Image size 1240x1240 · wide-field fundus photograph of an infant: 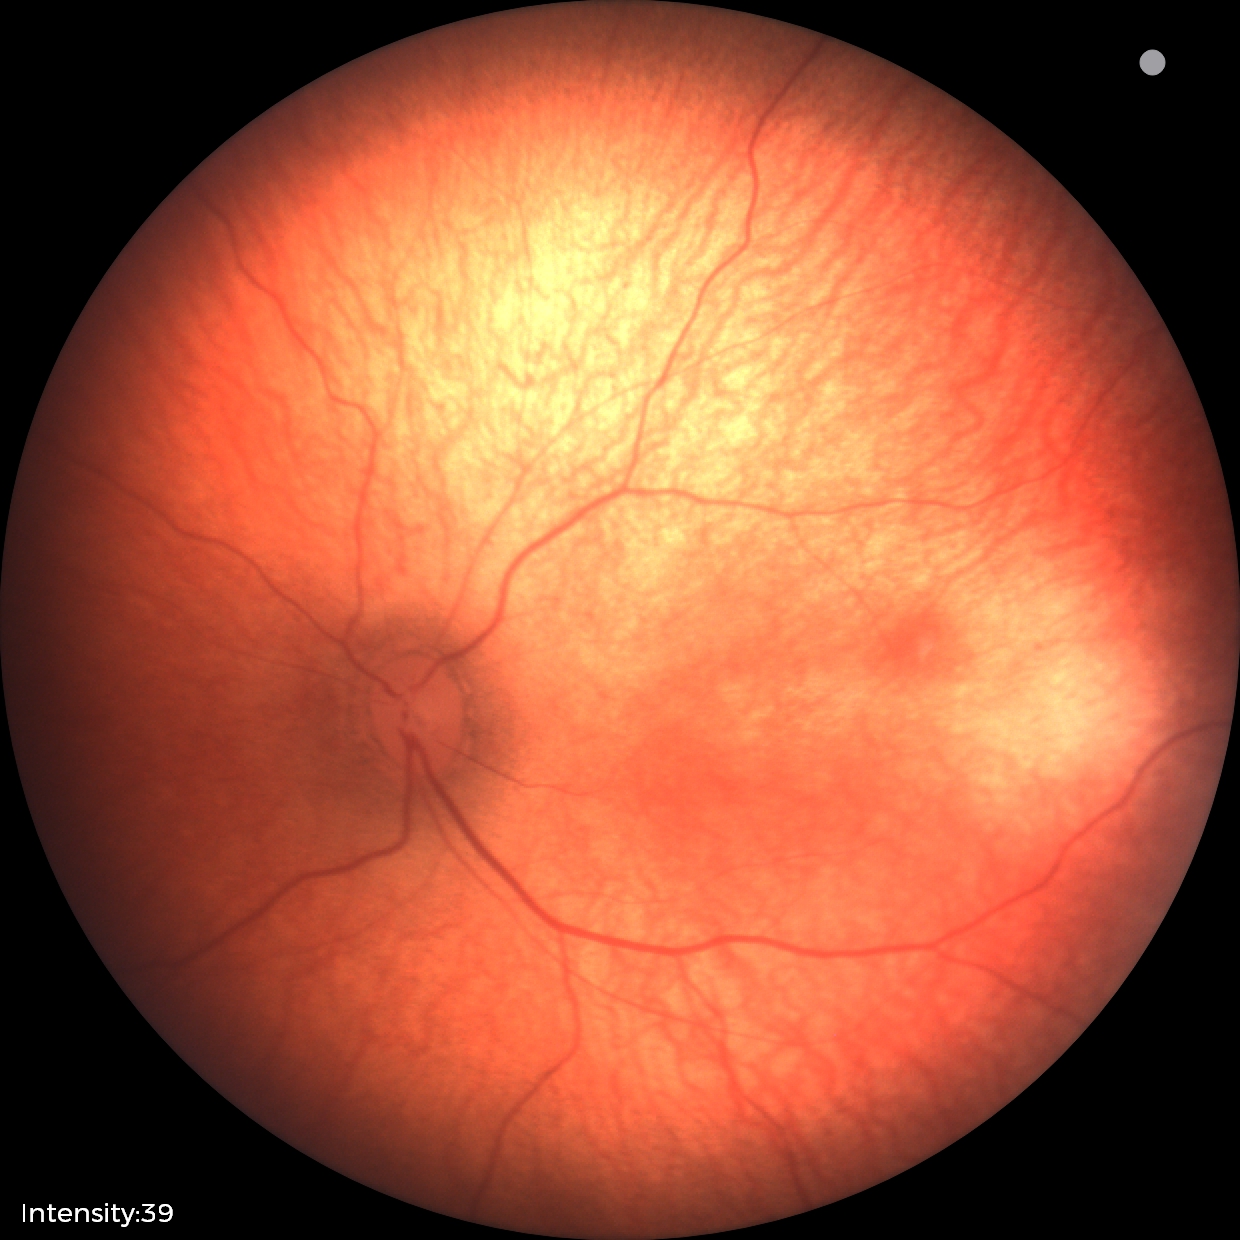
Physiological retinal appearance for postconceptual age.